Acquired with a Topcon TRC. Optic nerve head photograph.
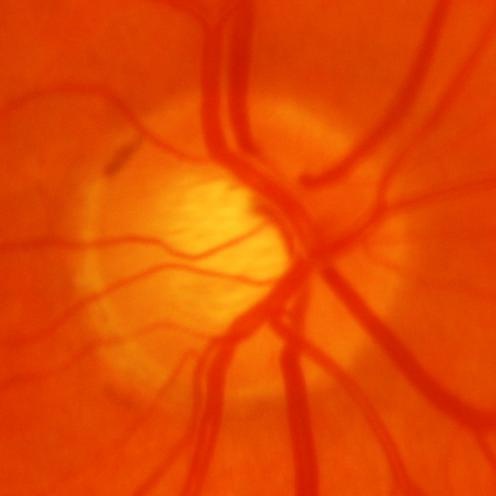 Glaucoma is present. Diagnosis = glaucomatous optic neuropathy.